No pharmacologic dilation · NIDEK AFC-230 · graded on the modified Davis scale — 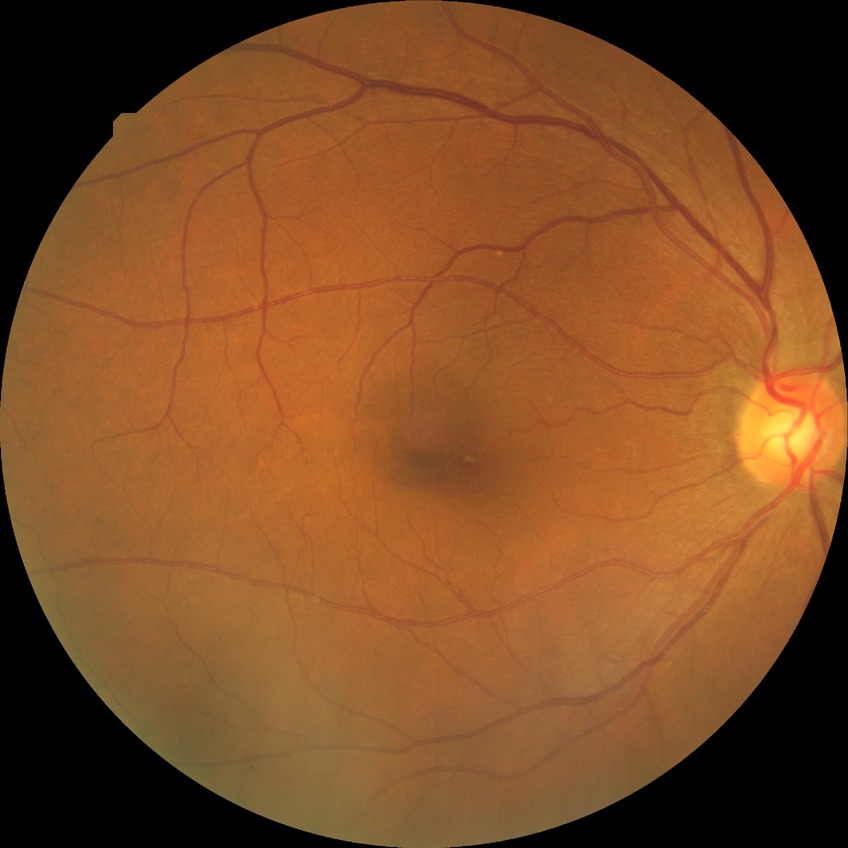

Davis grading: no diabetic retinopathy.